Retinal fundus photograph, macula-centered.
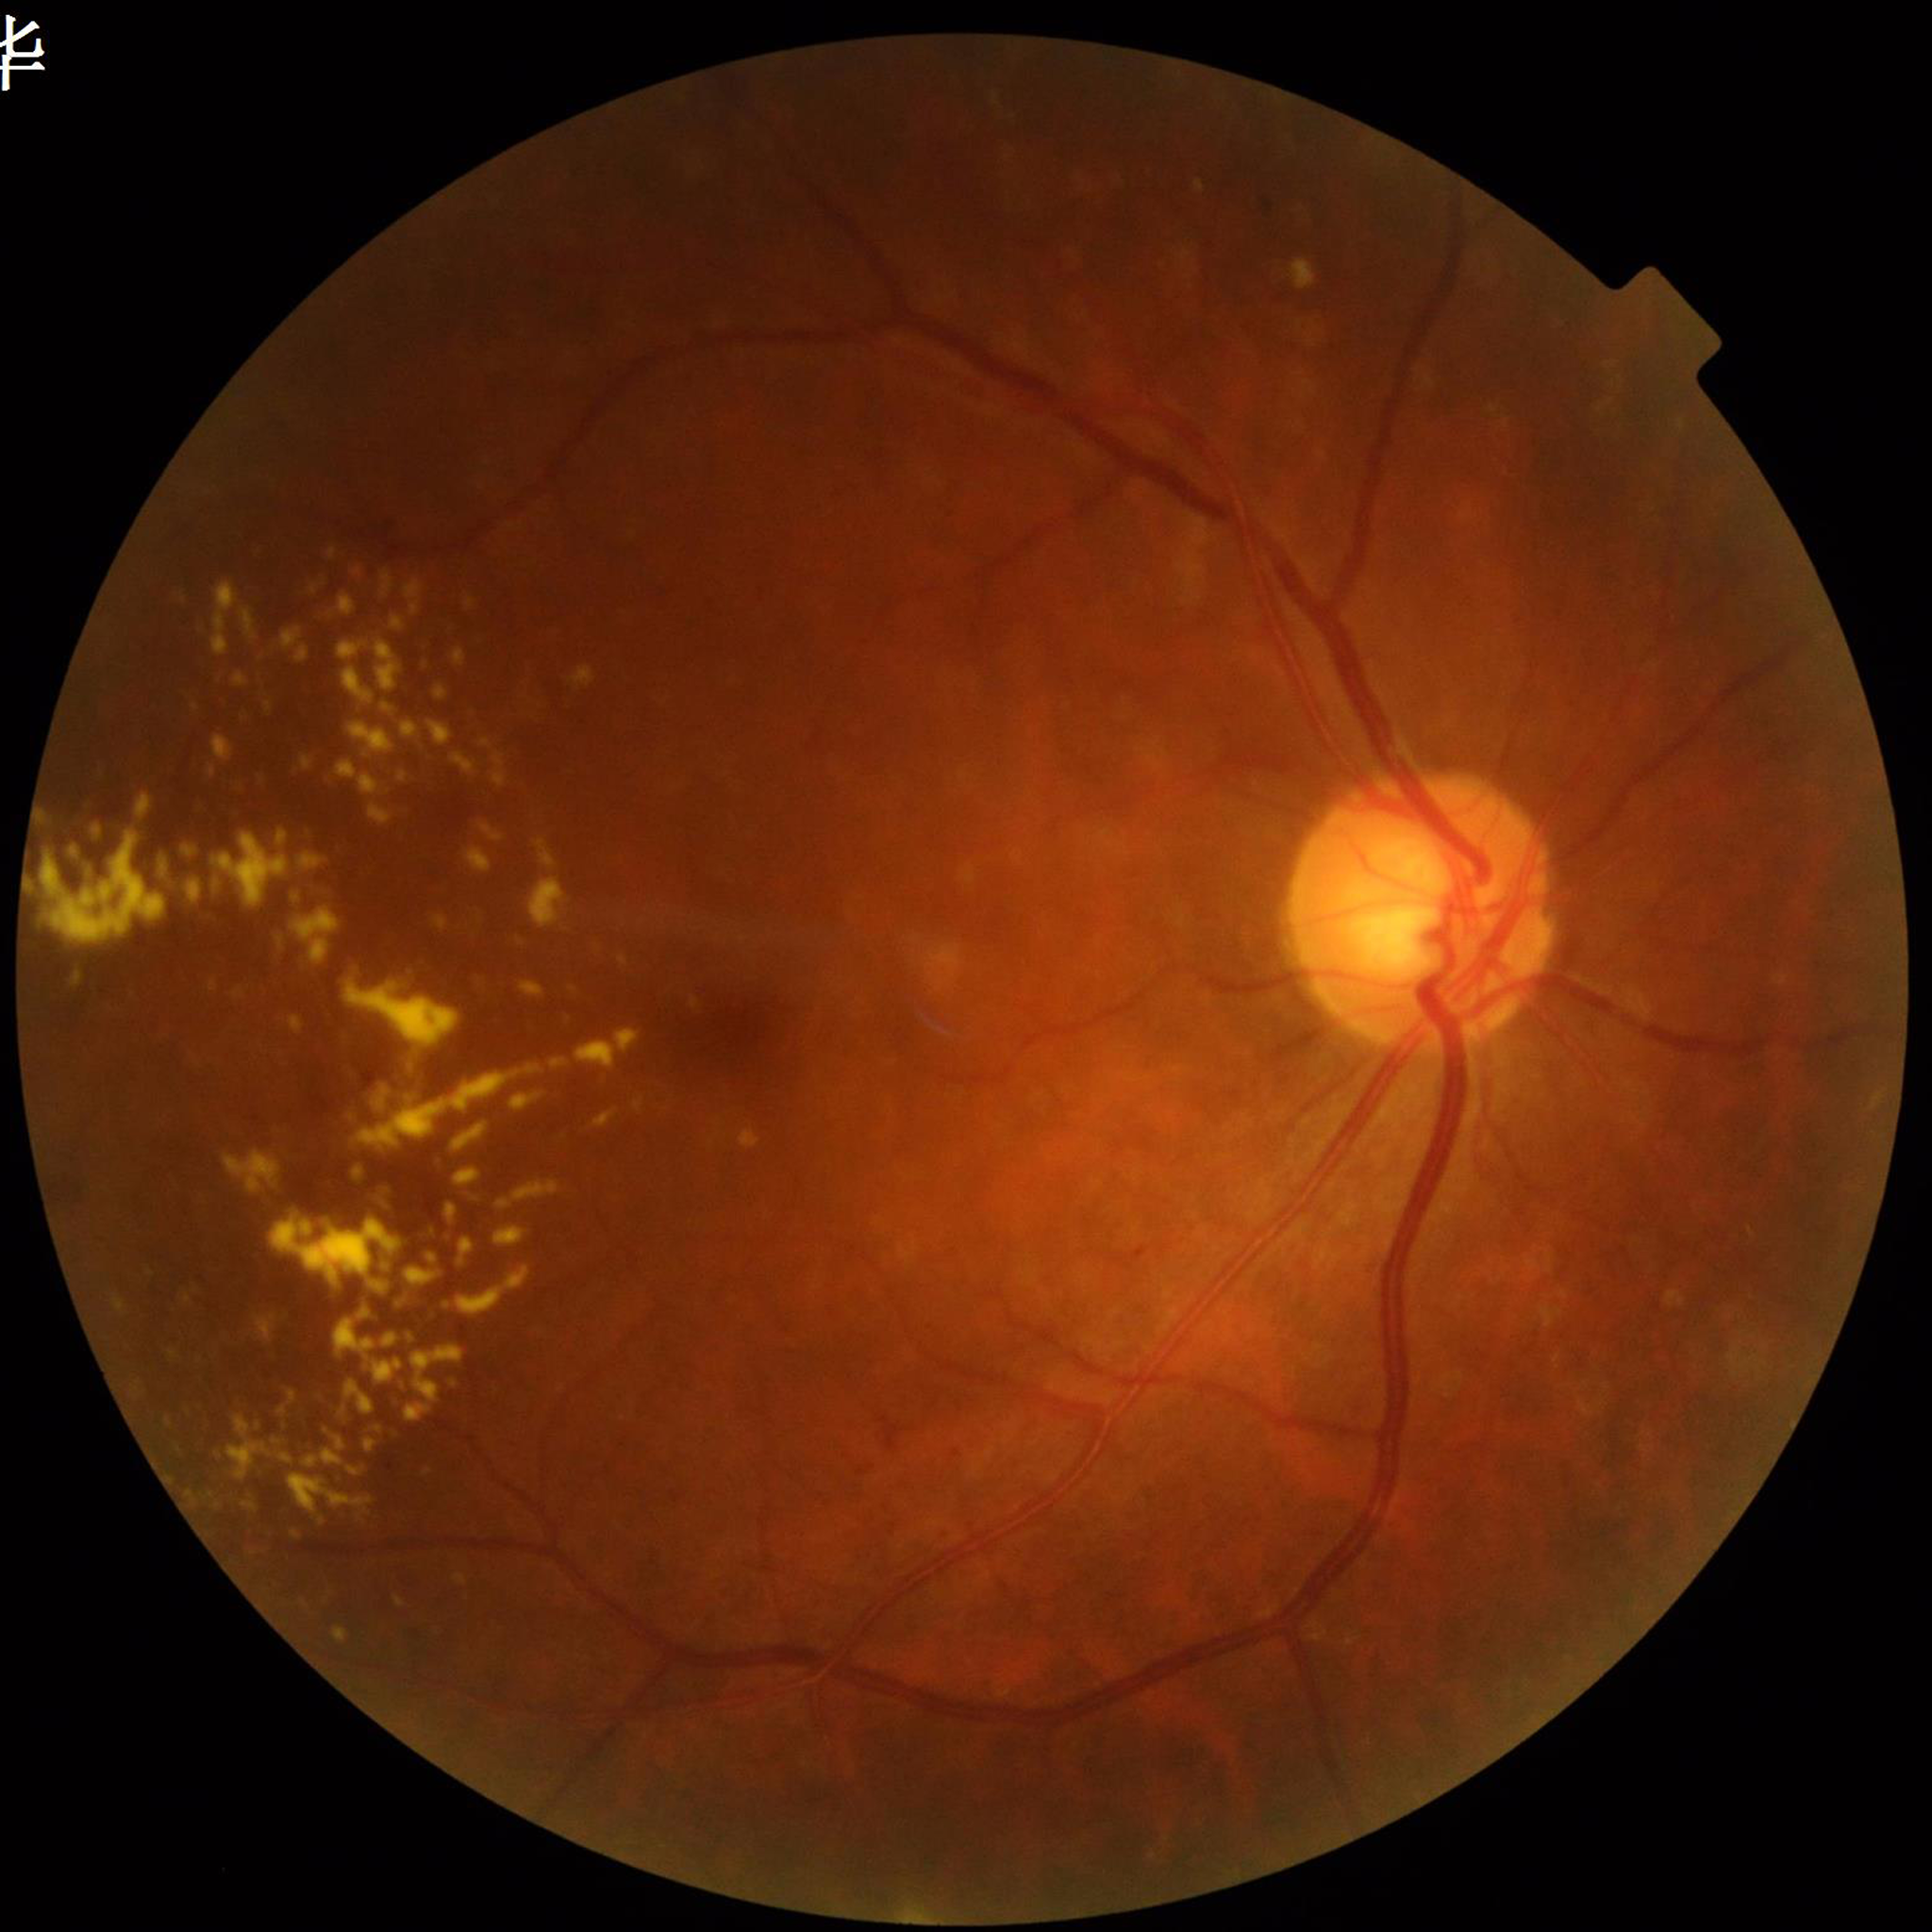

Photo quality: no blur, contrast adequate, illumination and color satisfactory. From a patient with diabetic retinopathy.